FOV: 45 degrees: 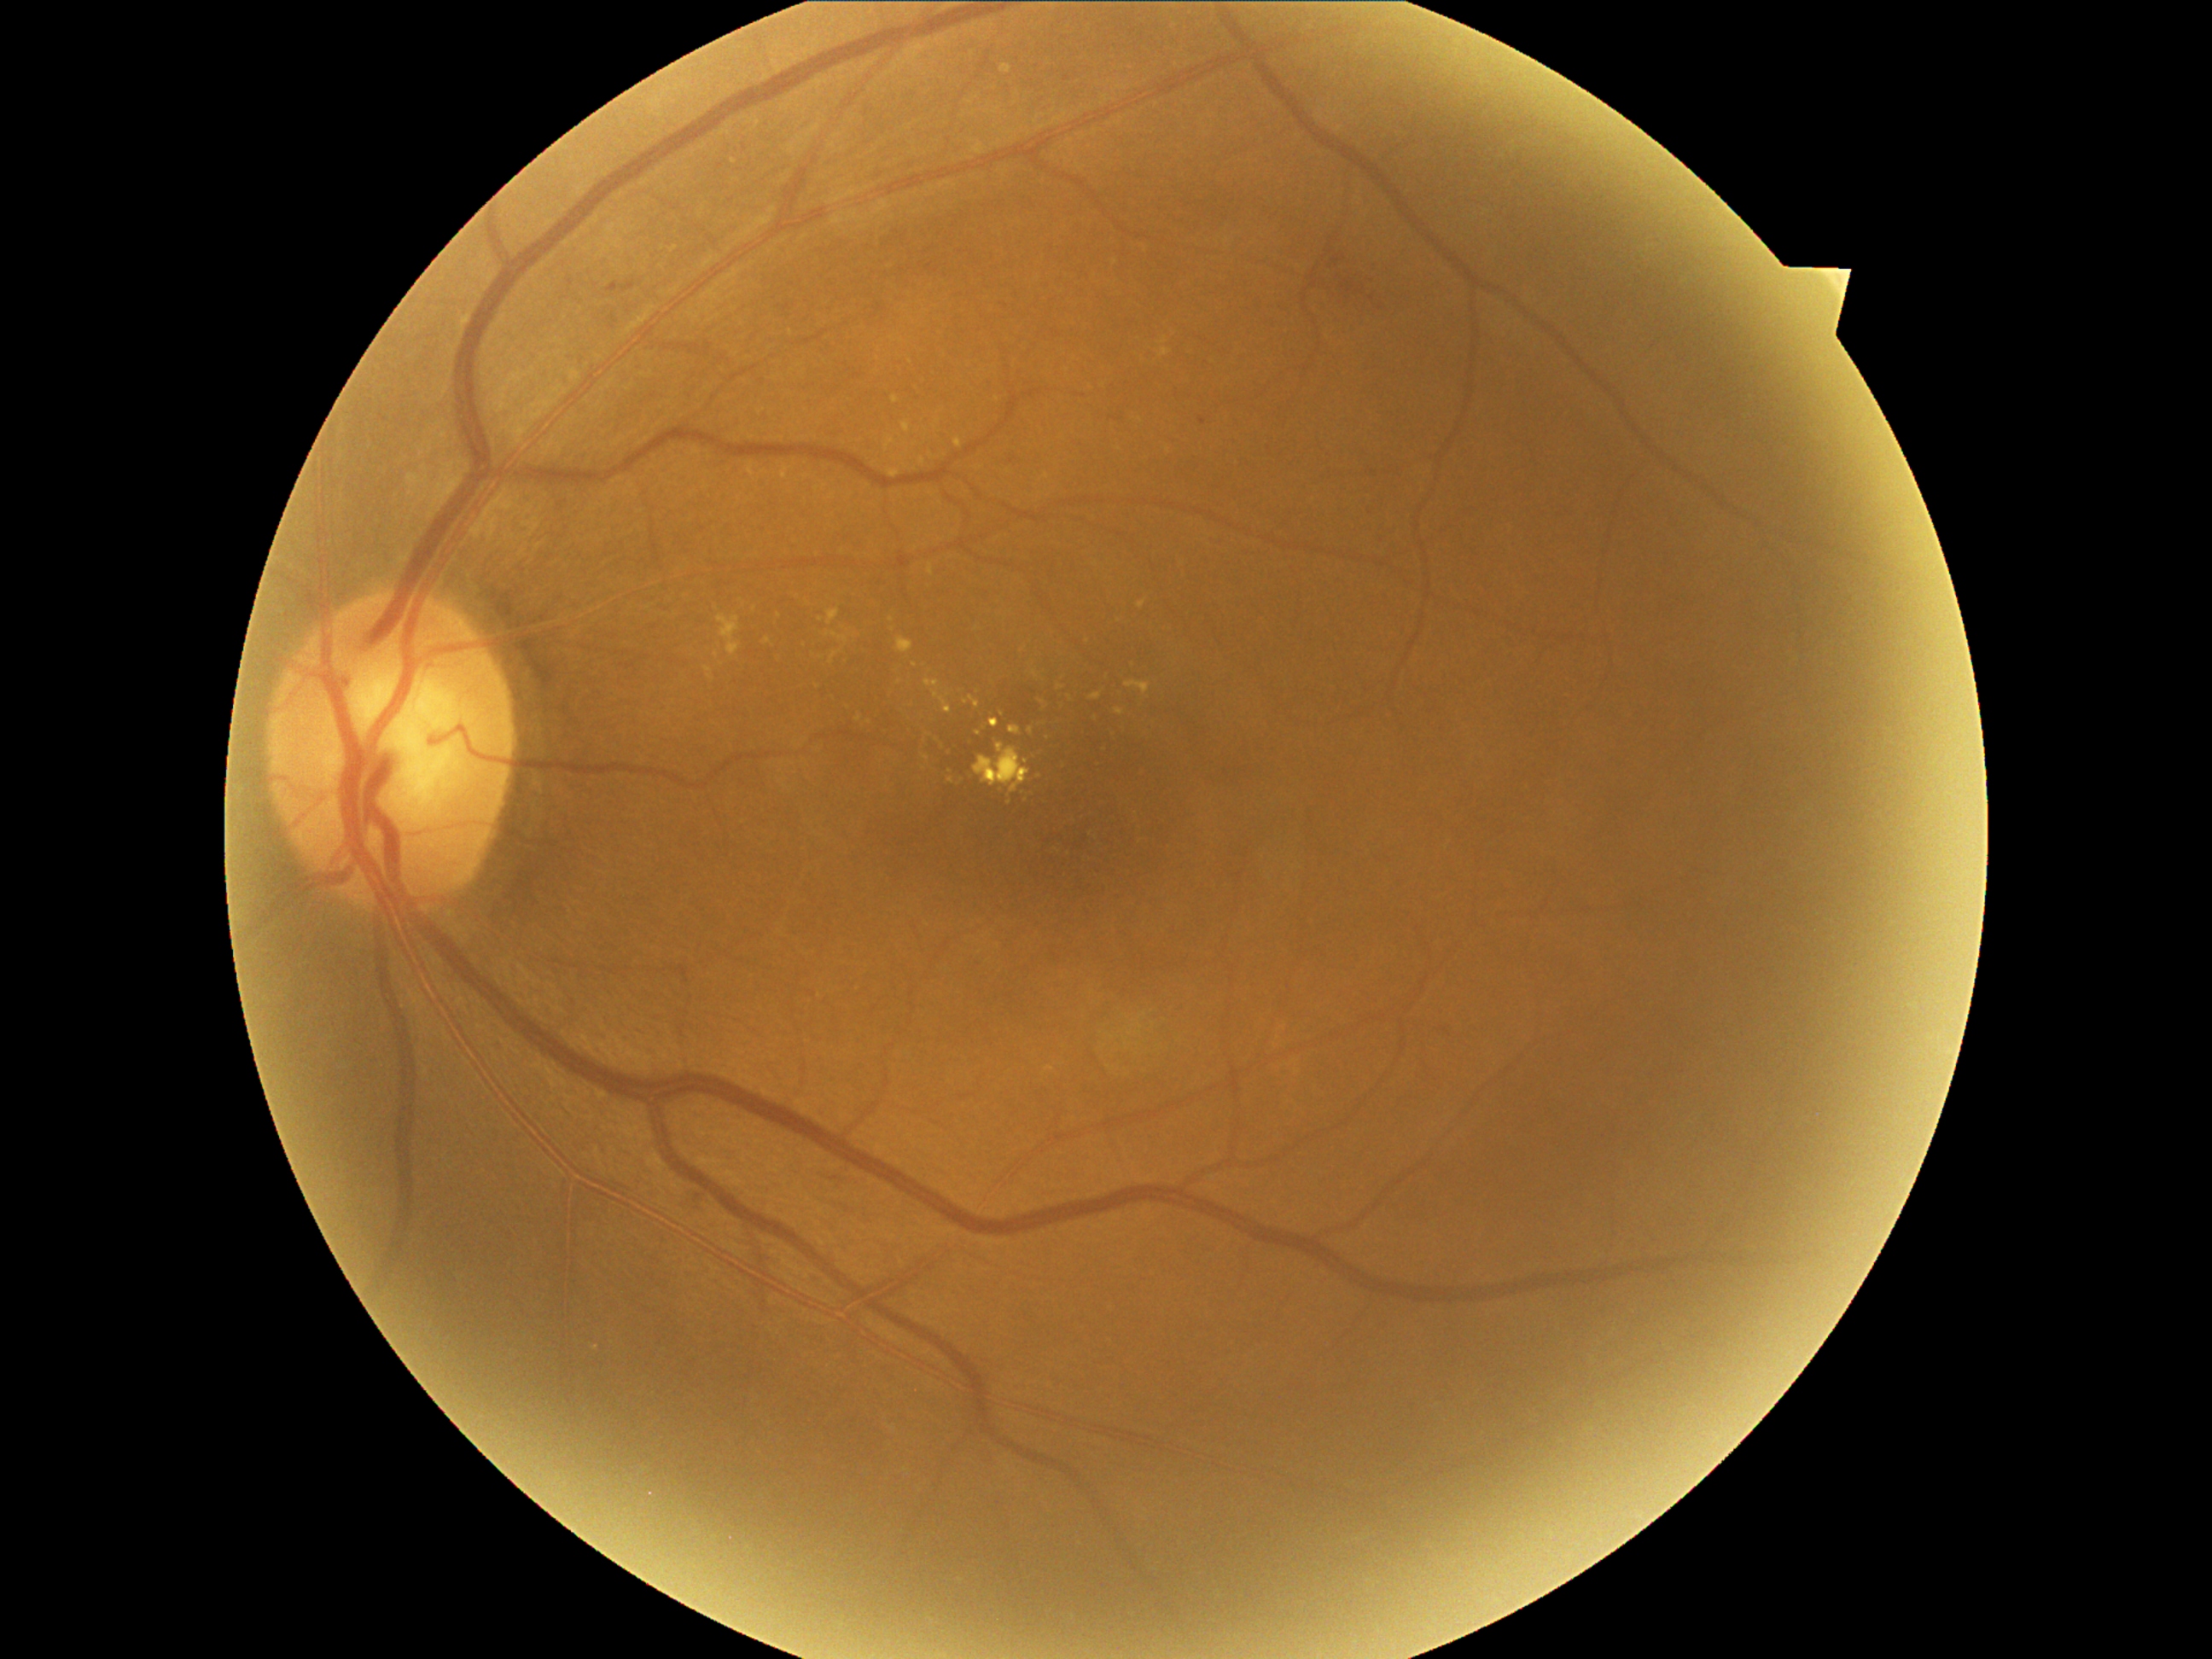

diabetic retinopathy (DR): grade 2 (moderate NPDR).